Posterior pole color fundus photograph; modified Davis classification.
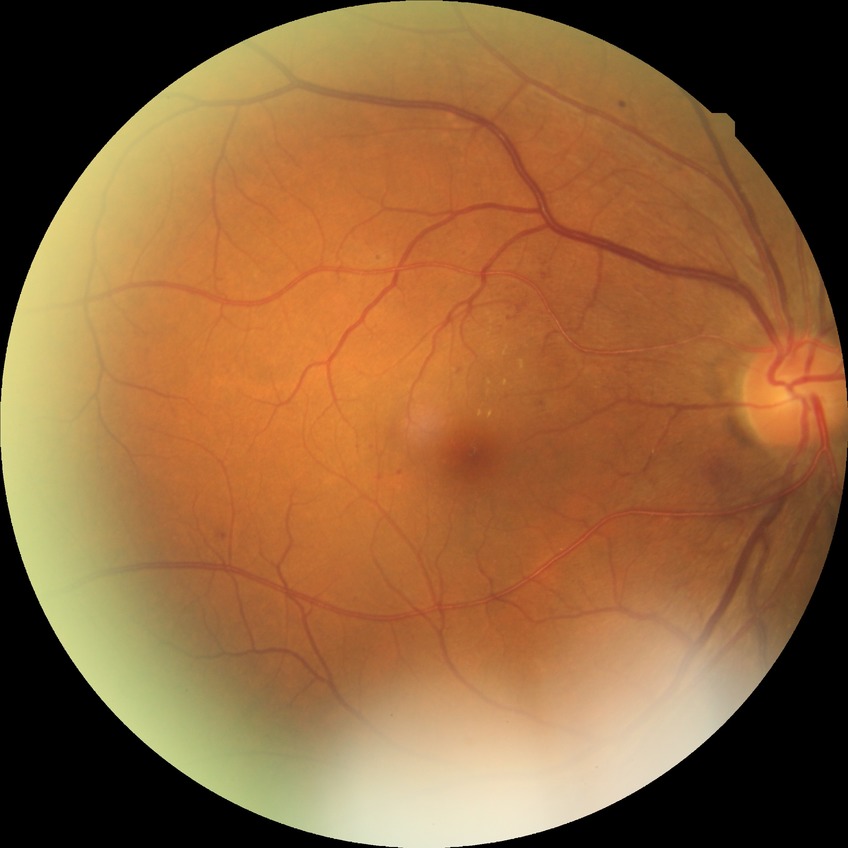

Retinopathy grade: simple diabetic retinopathy.